NIDEK AFC-230 fundus camera, no pharmacologic dilation:
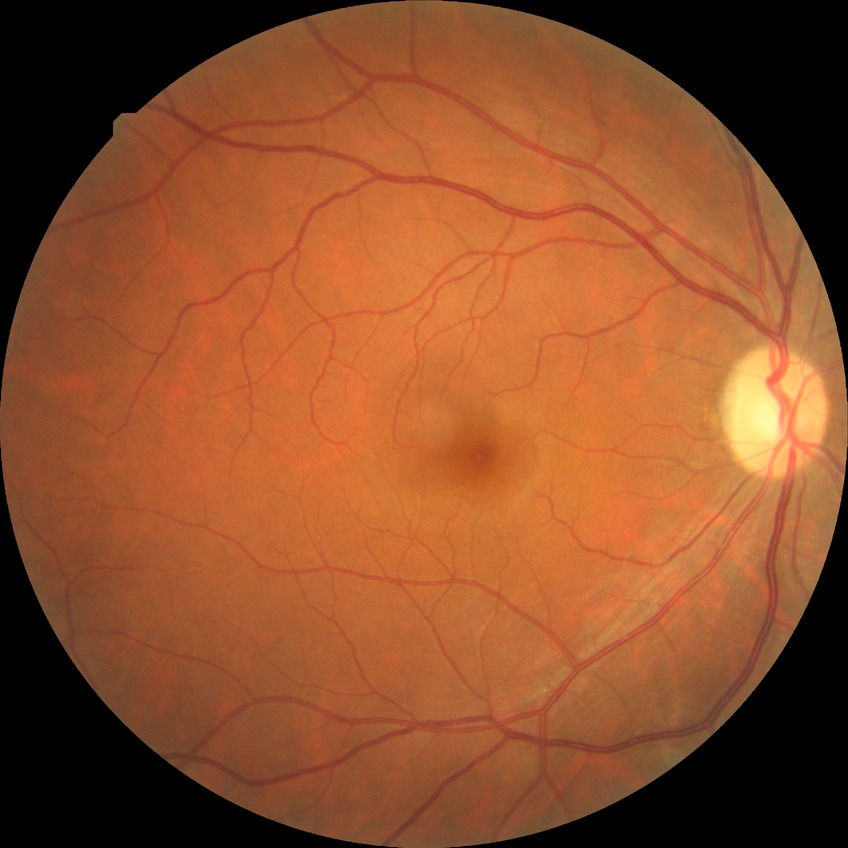

Davis grading: no diabetic retinopathy.